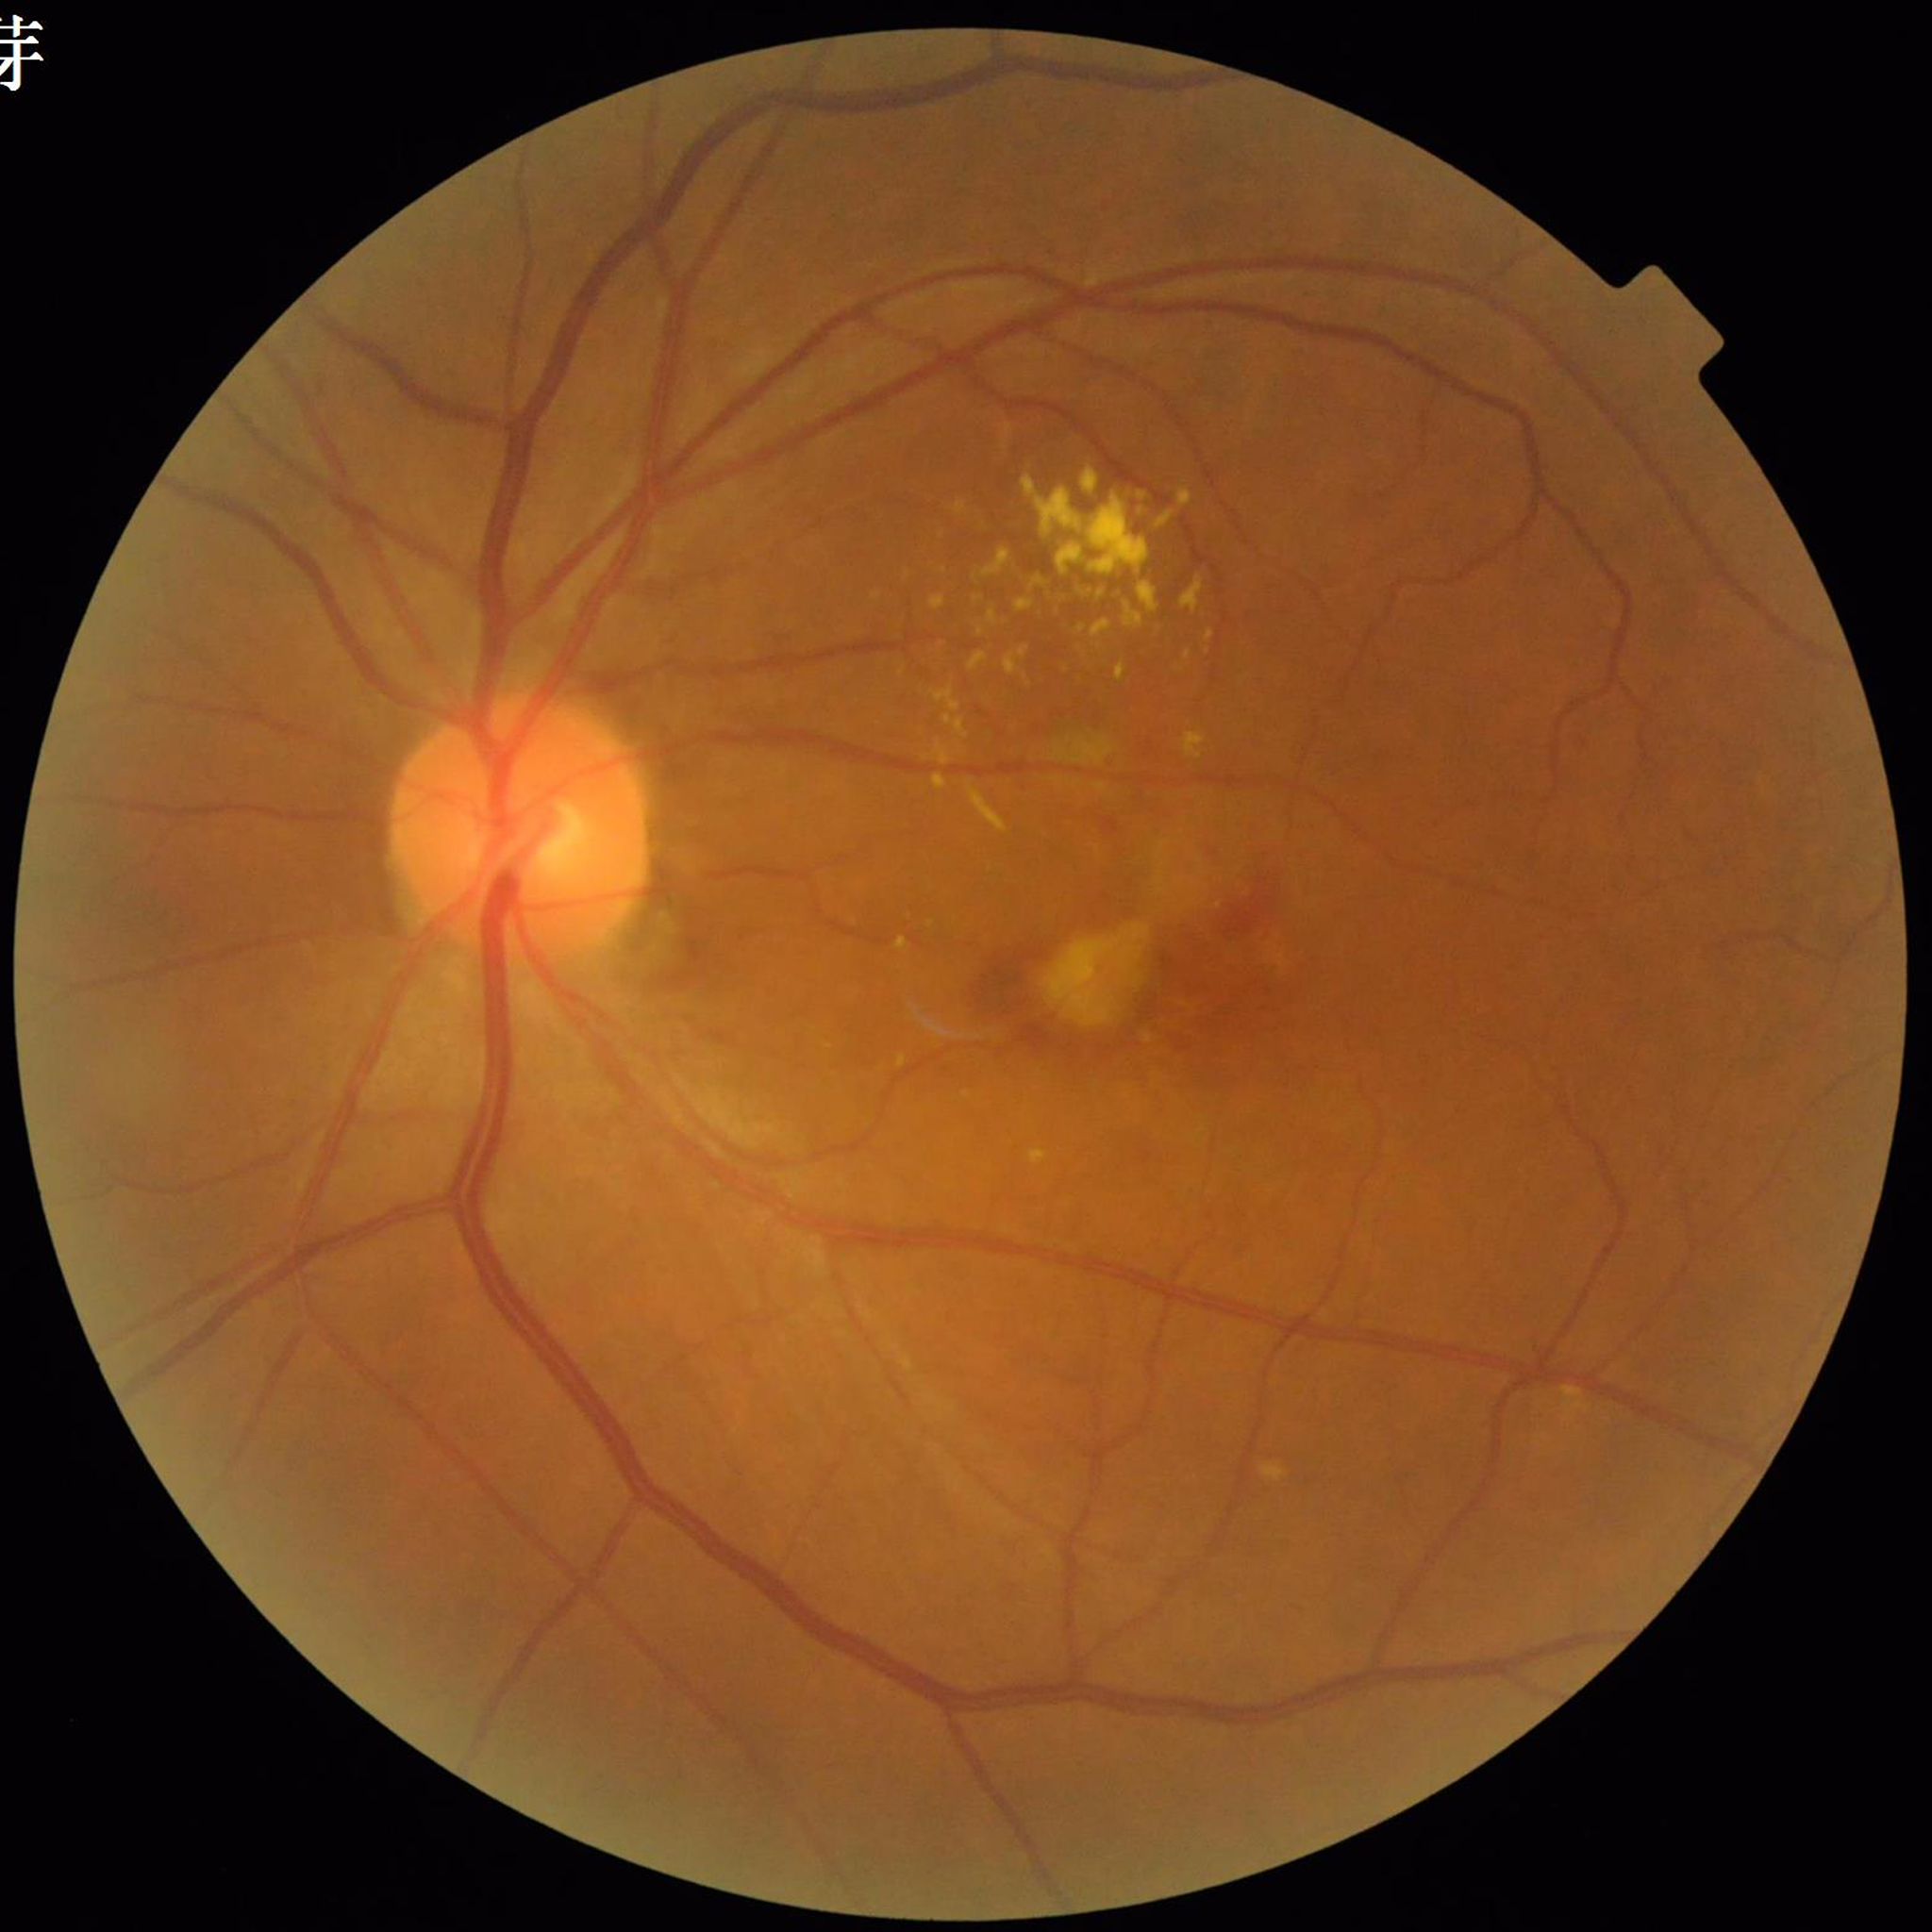
Diagnosis = age-related macular degeneration (AMD).